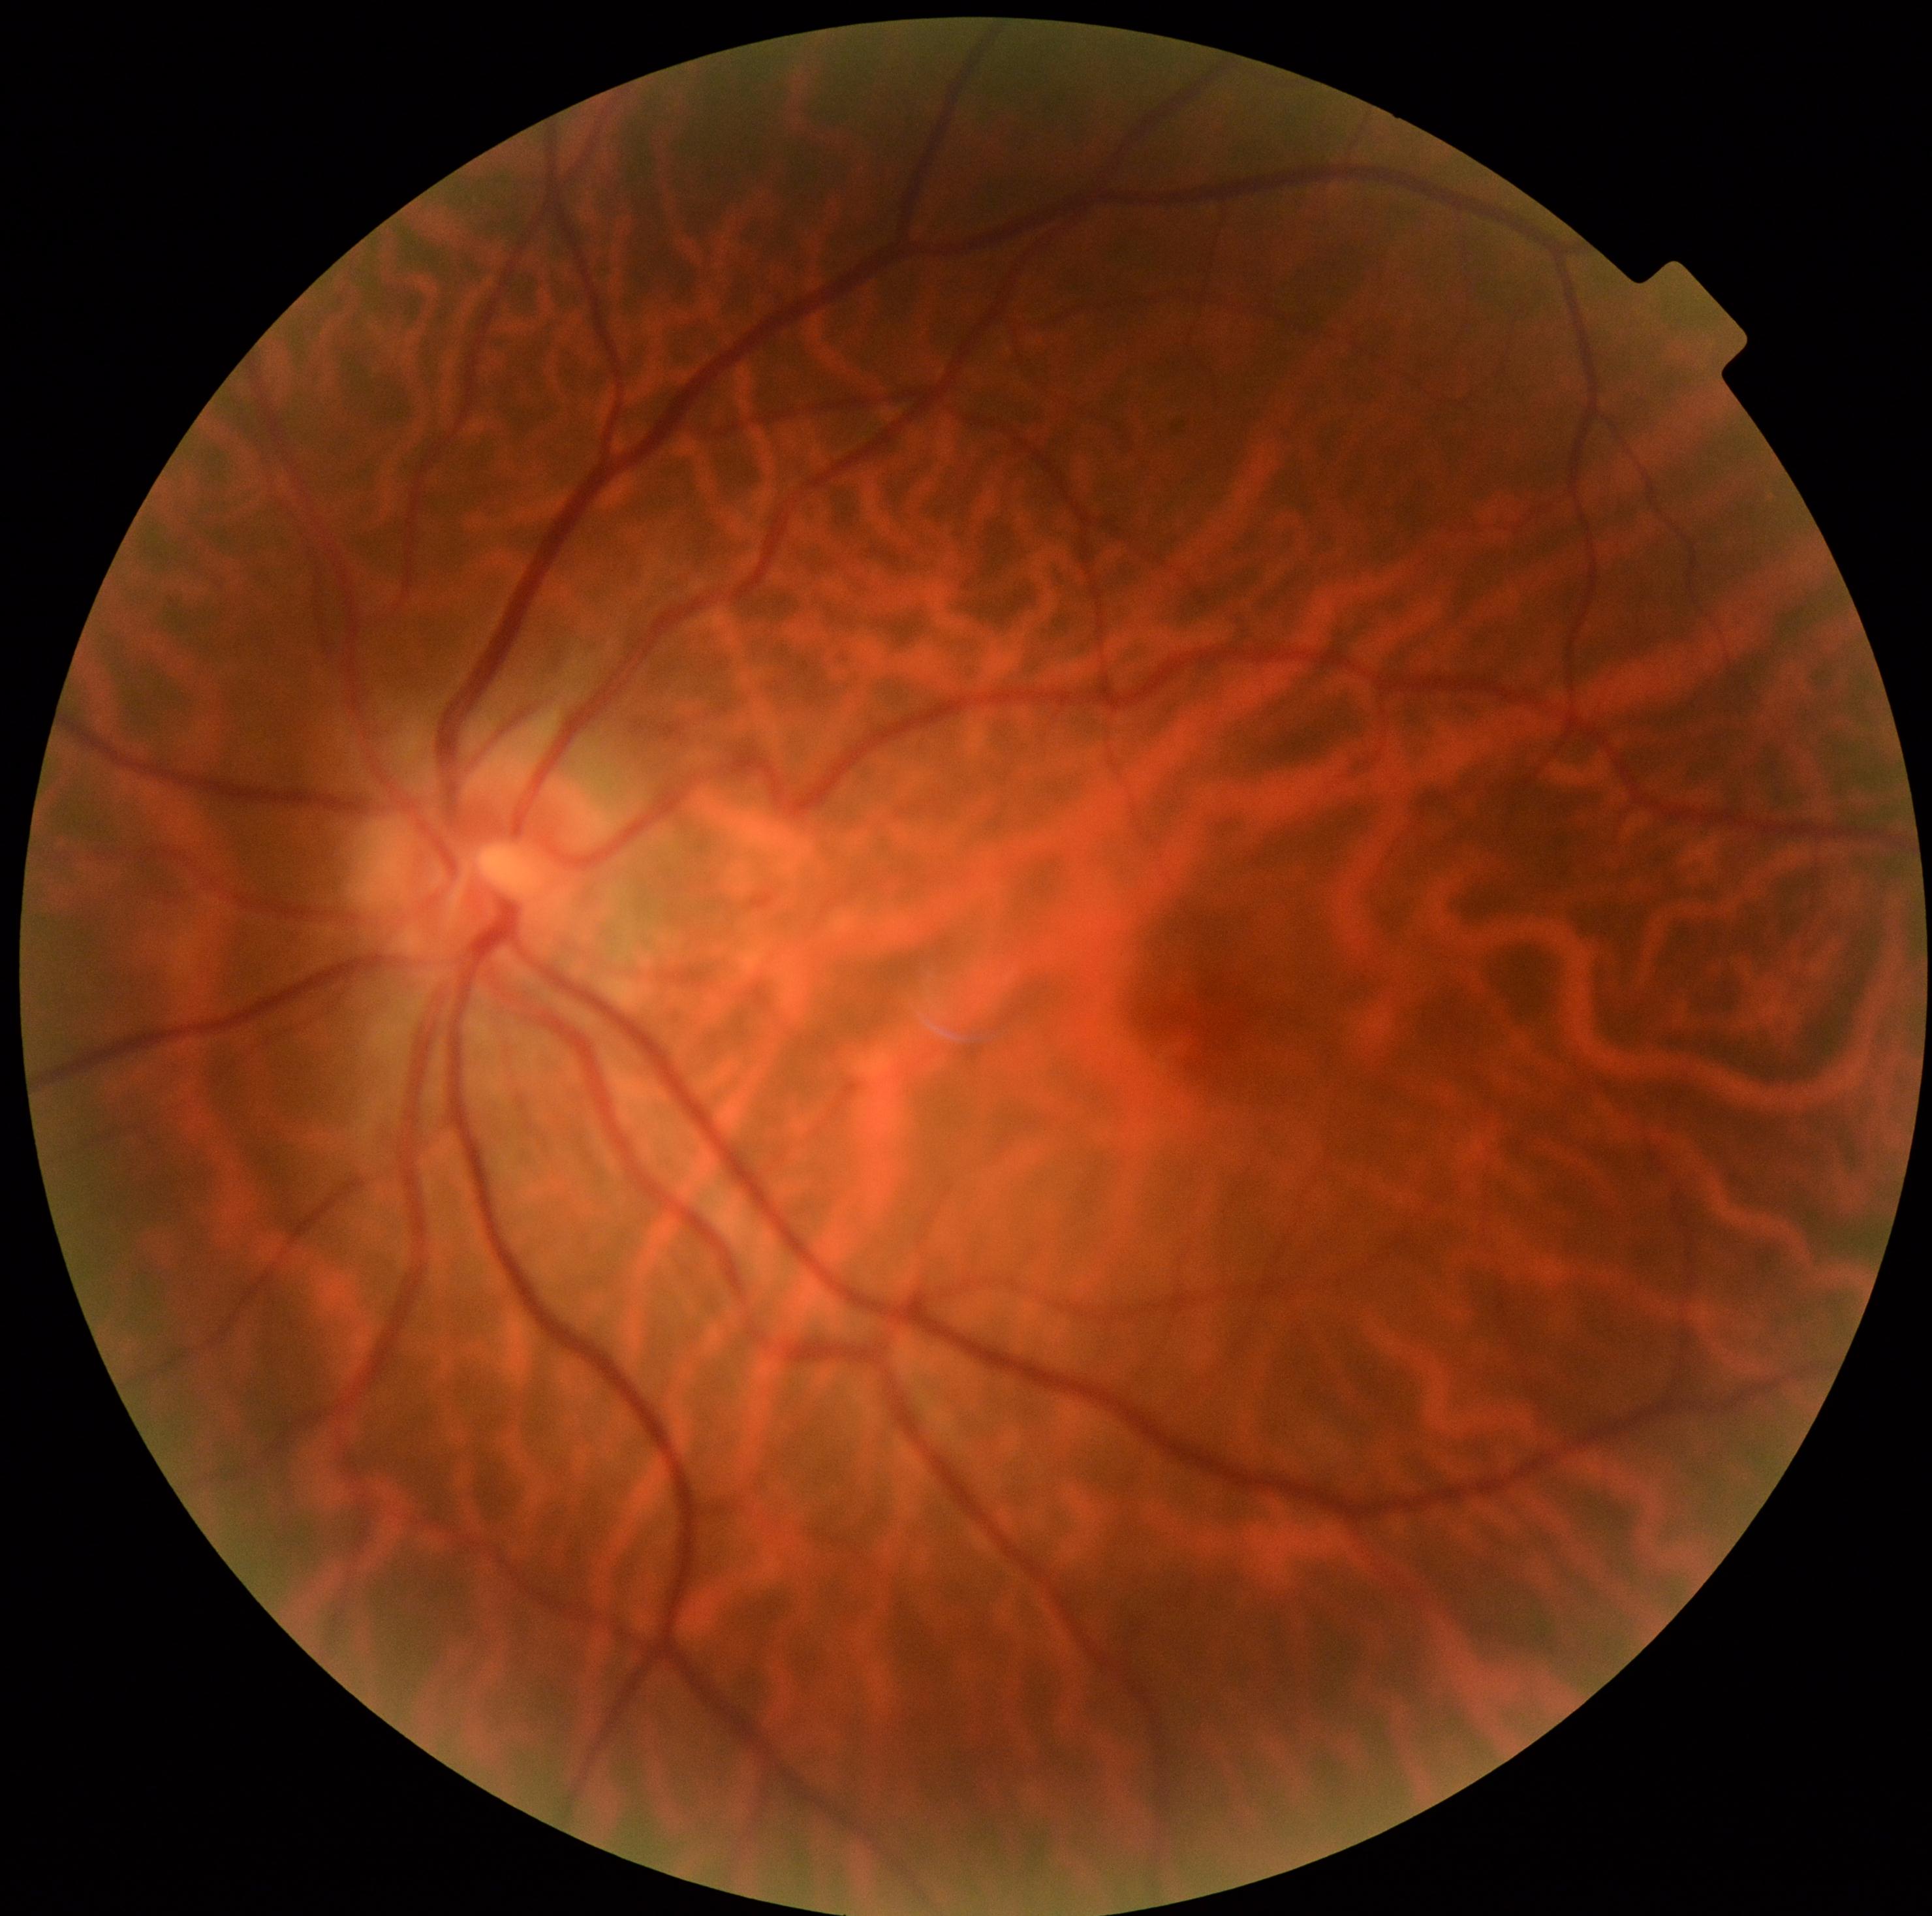

Findings:
– diabetic retinopathy — grade 0 (no apparent retinopathy)